2212 by 1659 pixels: 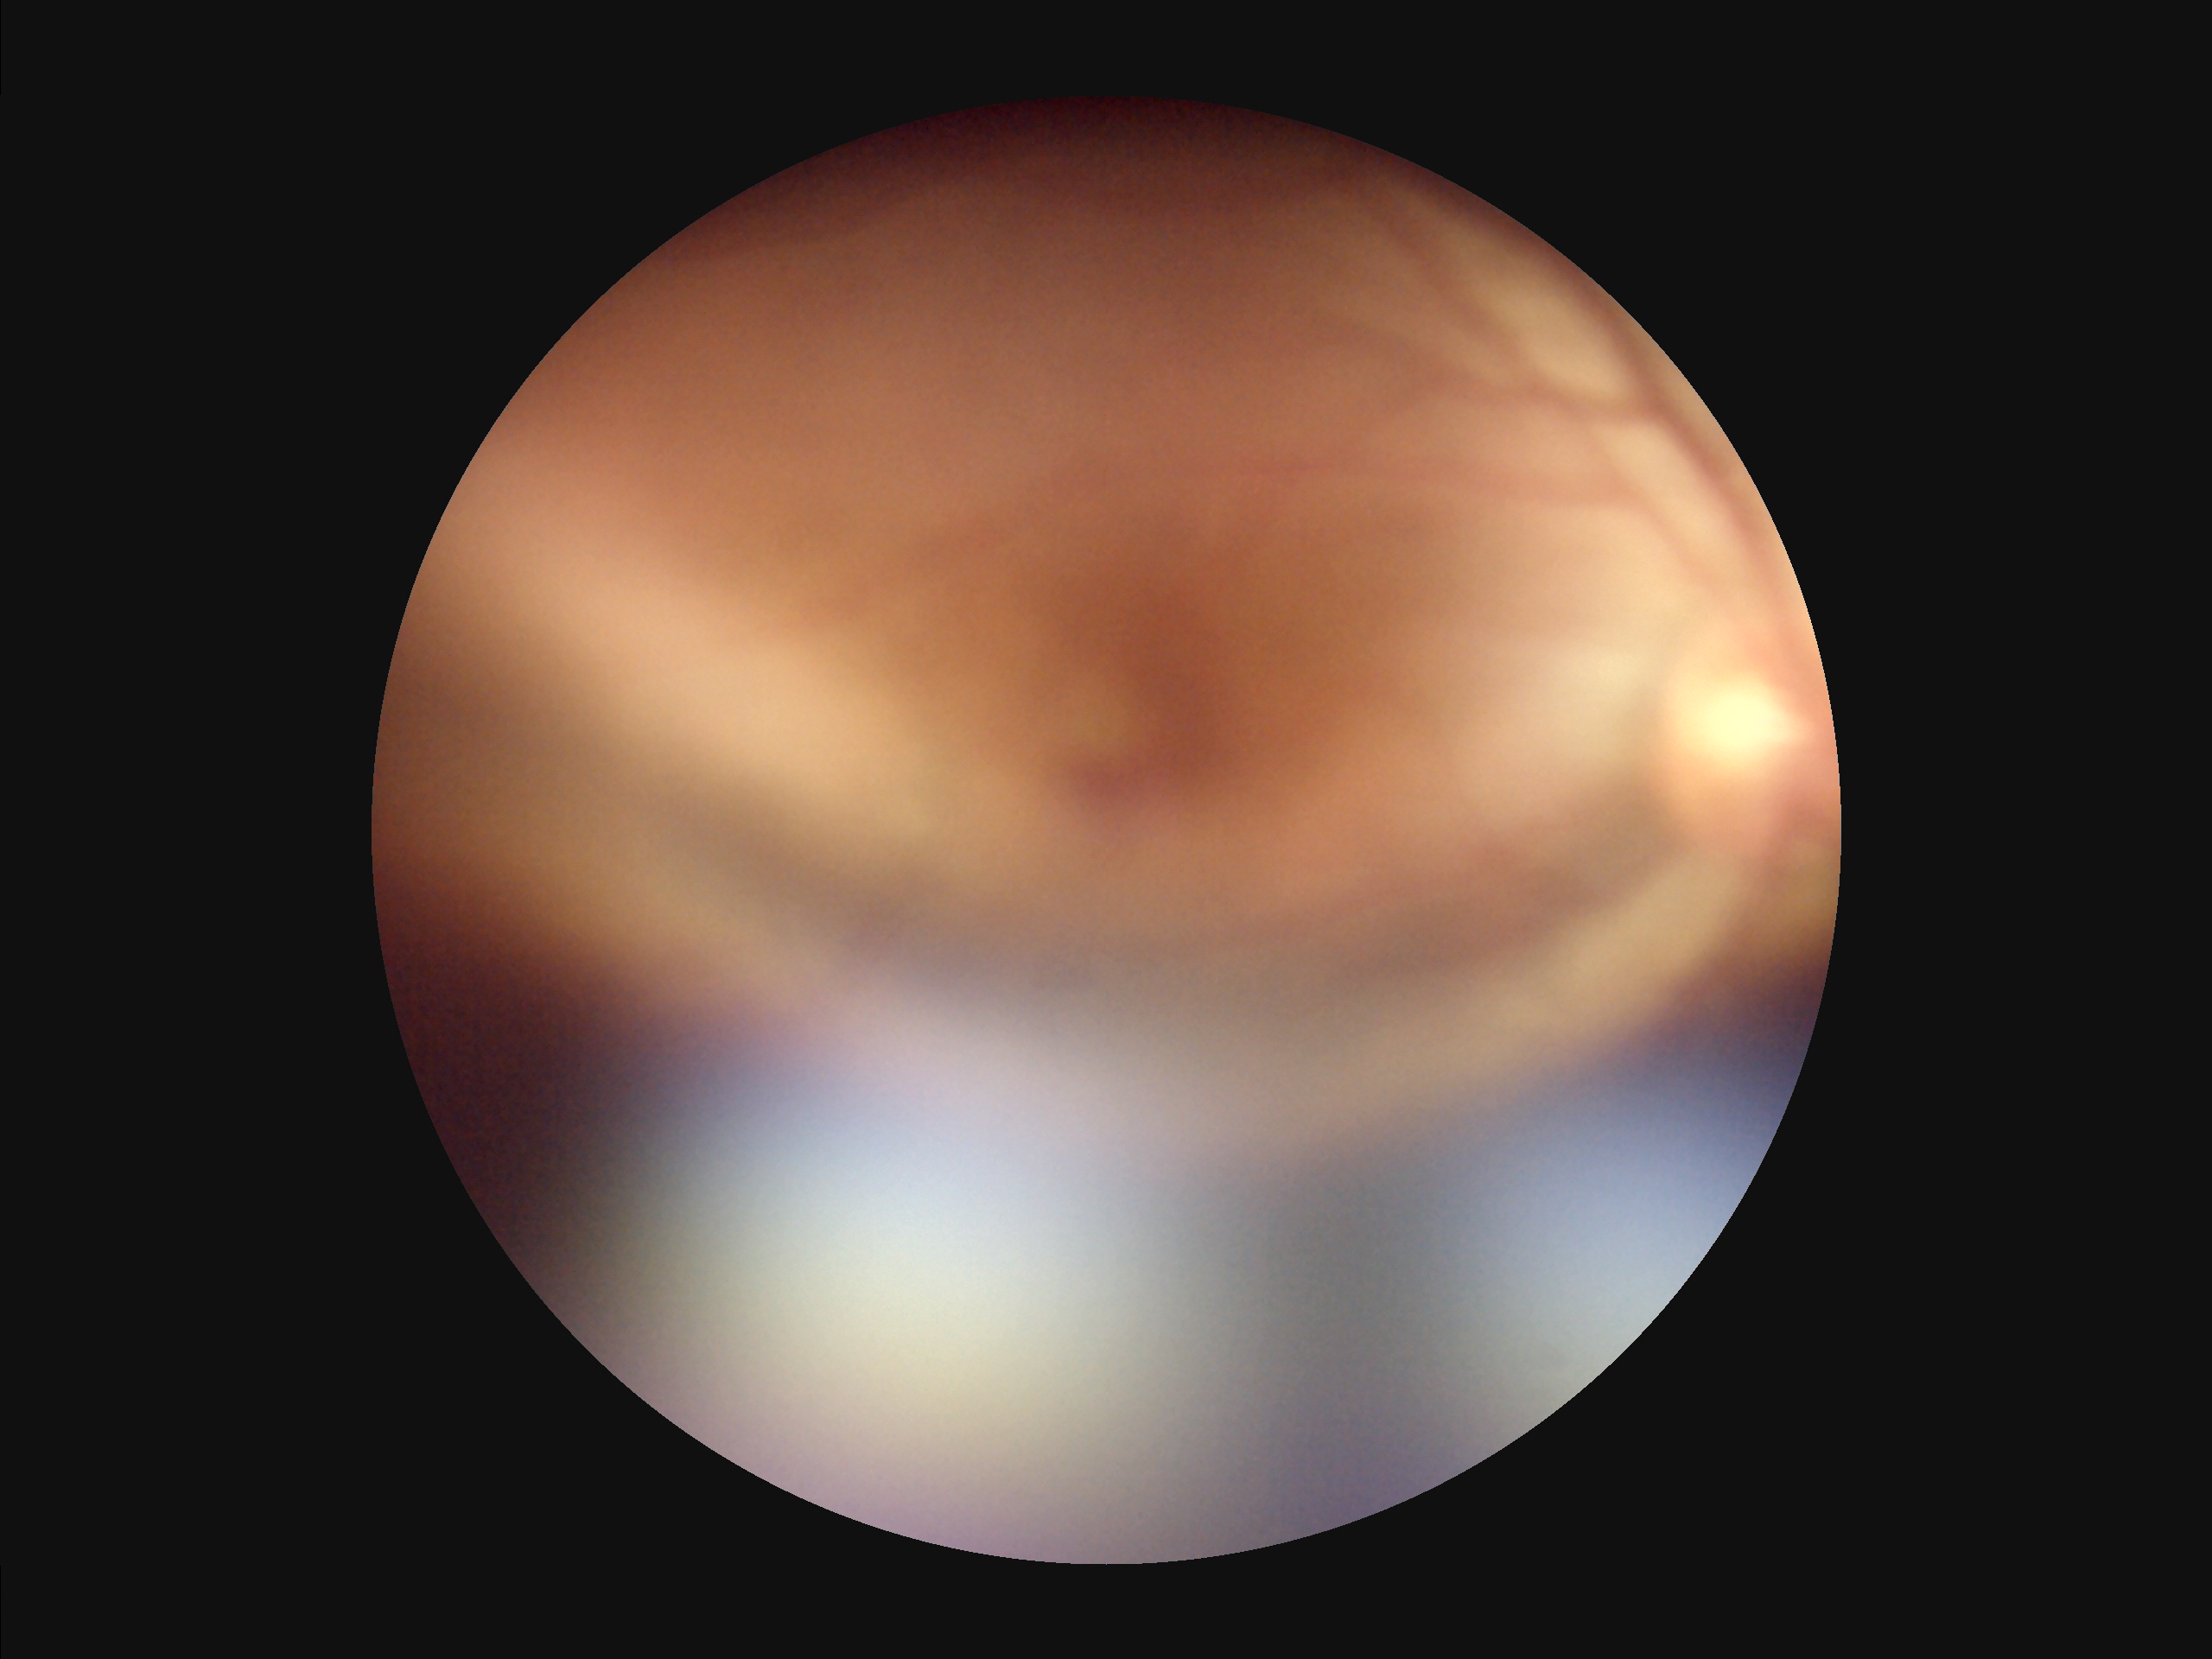
Quality assessment: focus: reduced | contrast: reduced | illumination/color: uneven | overall: low.